Infant wide-field retinal image.
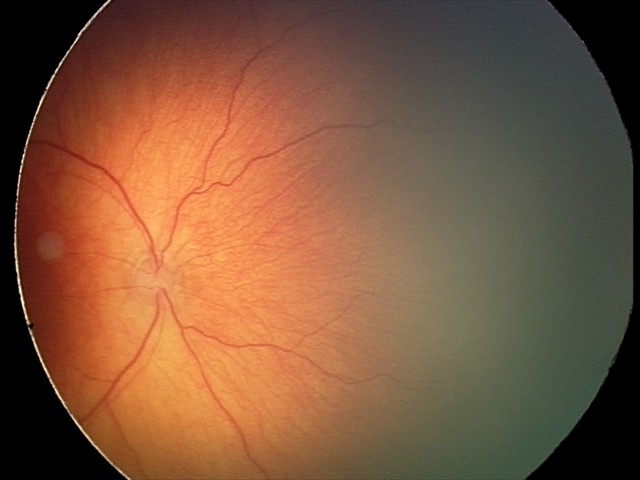 Diagnosis from this screening exam: ROP stage 1.